Davis DR grading · camera: NIDEK AFC-230.
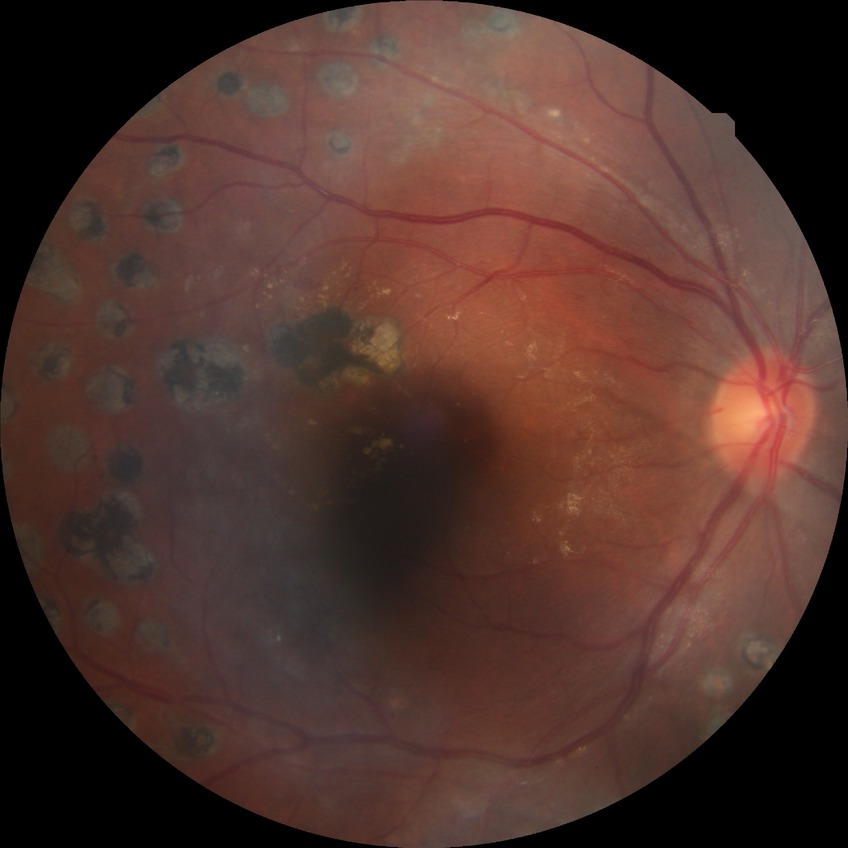
Modified Davis grade: PDR.